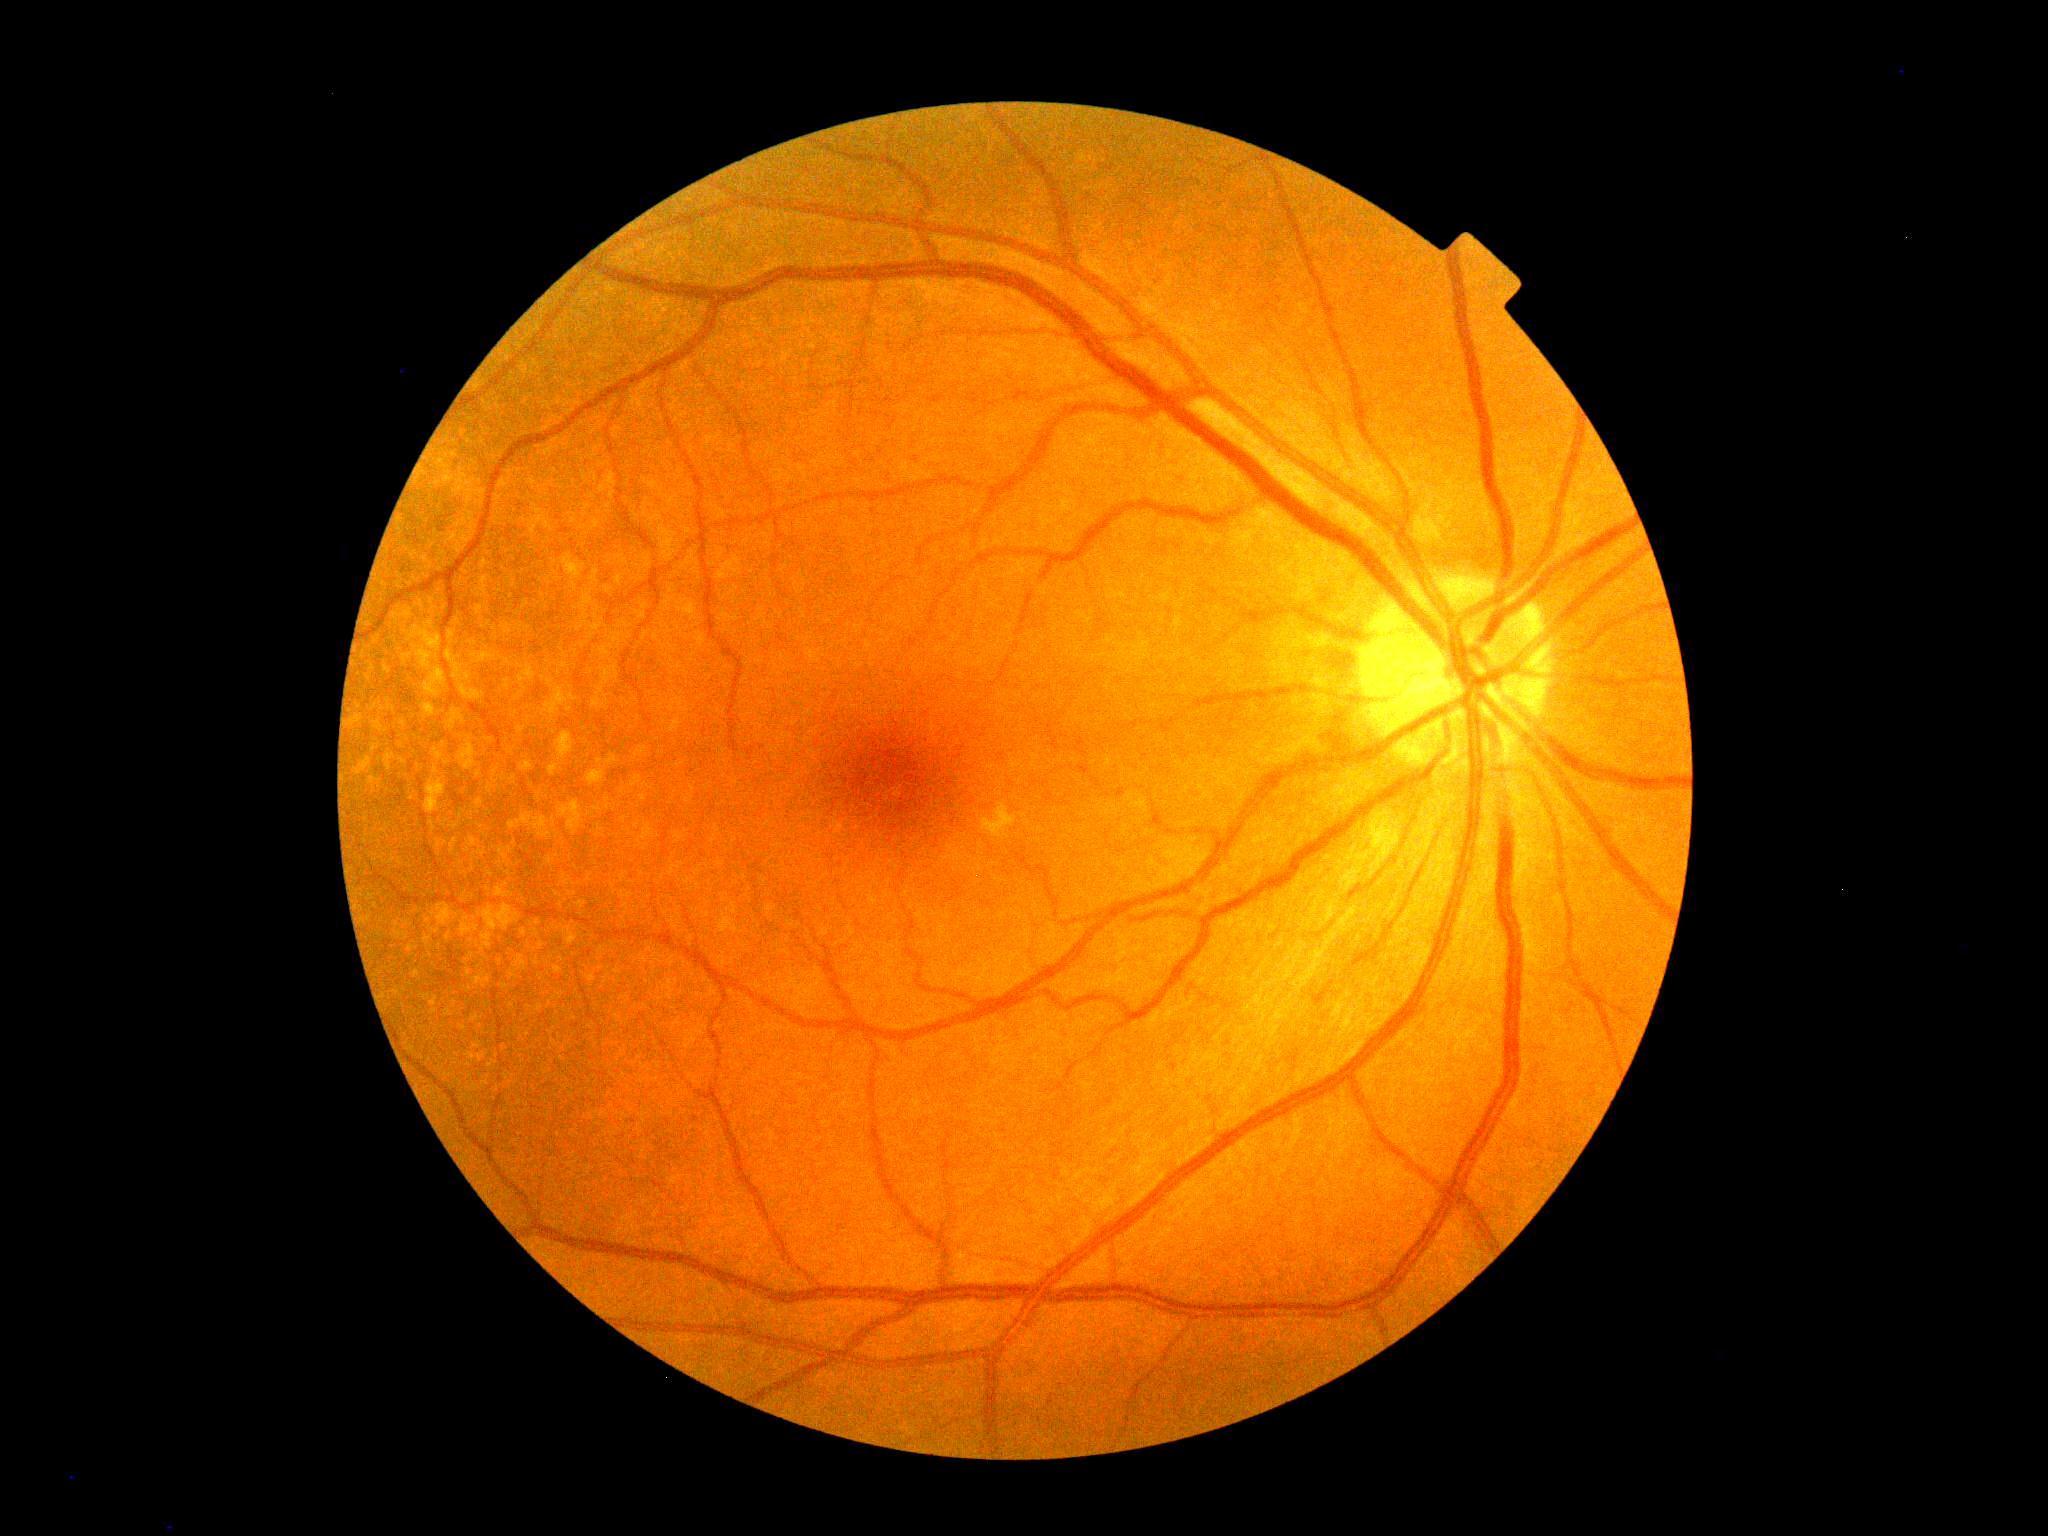

{
  "dr_grade": "no apparent retinopathy (grade 0)",
  "dr_impression": "no DR findings"
}